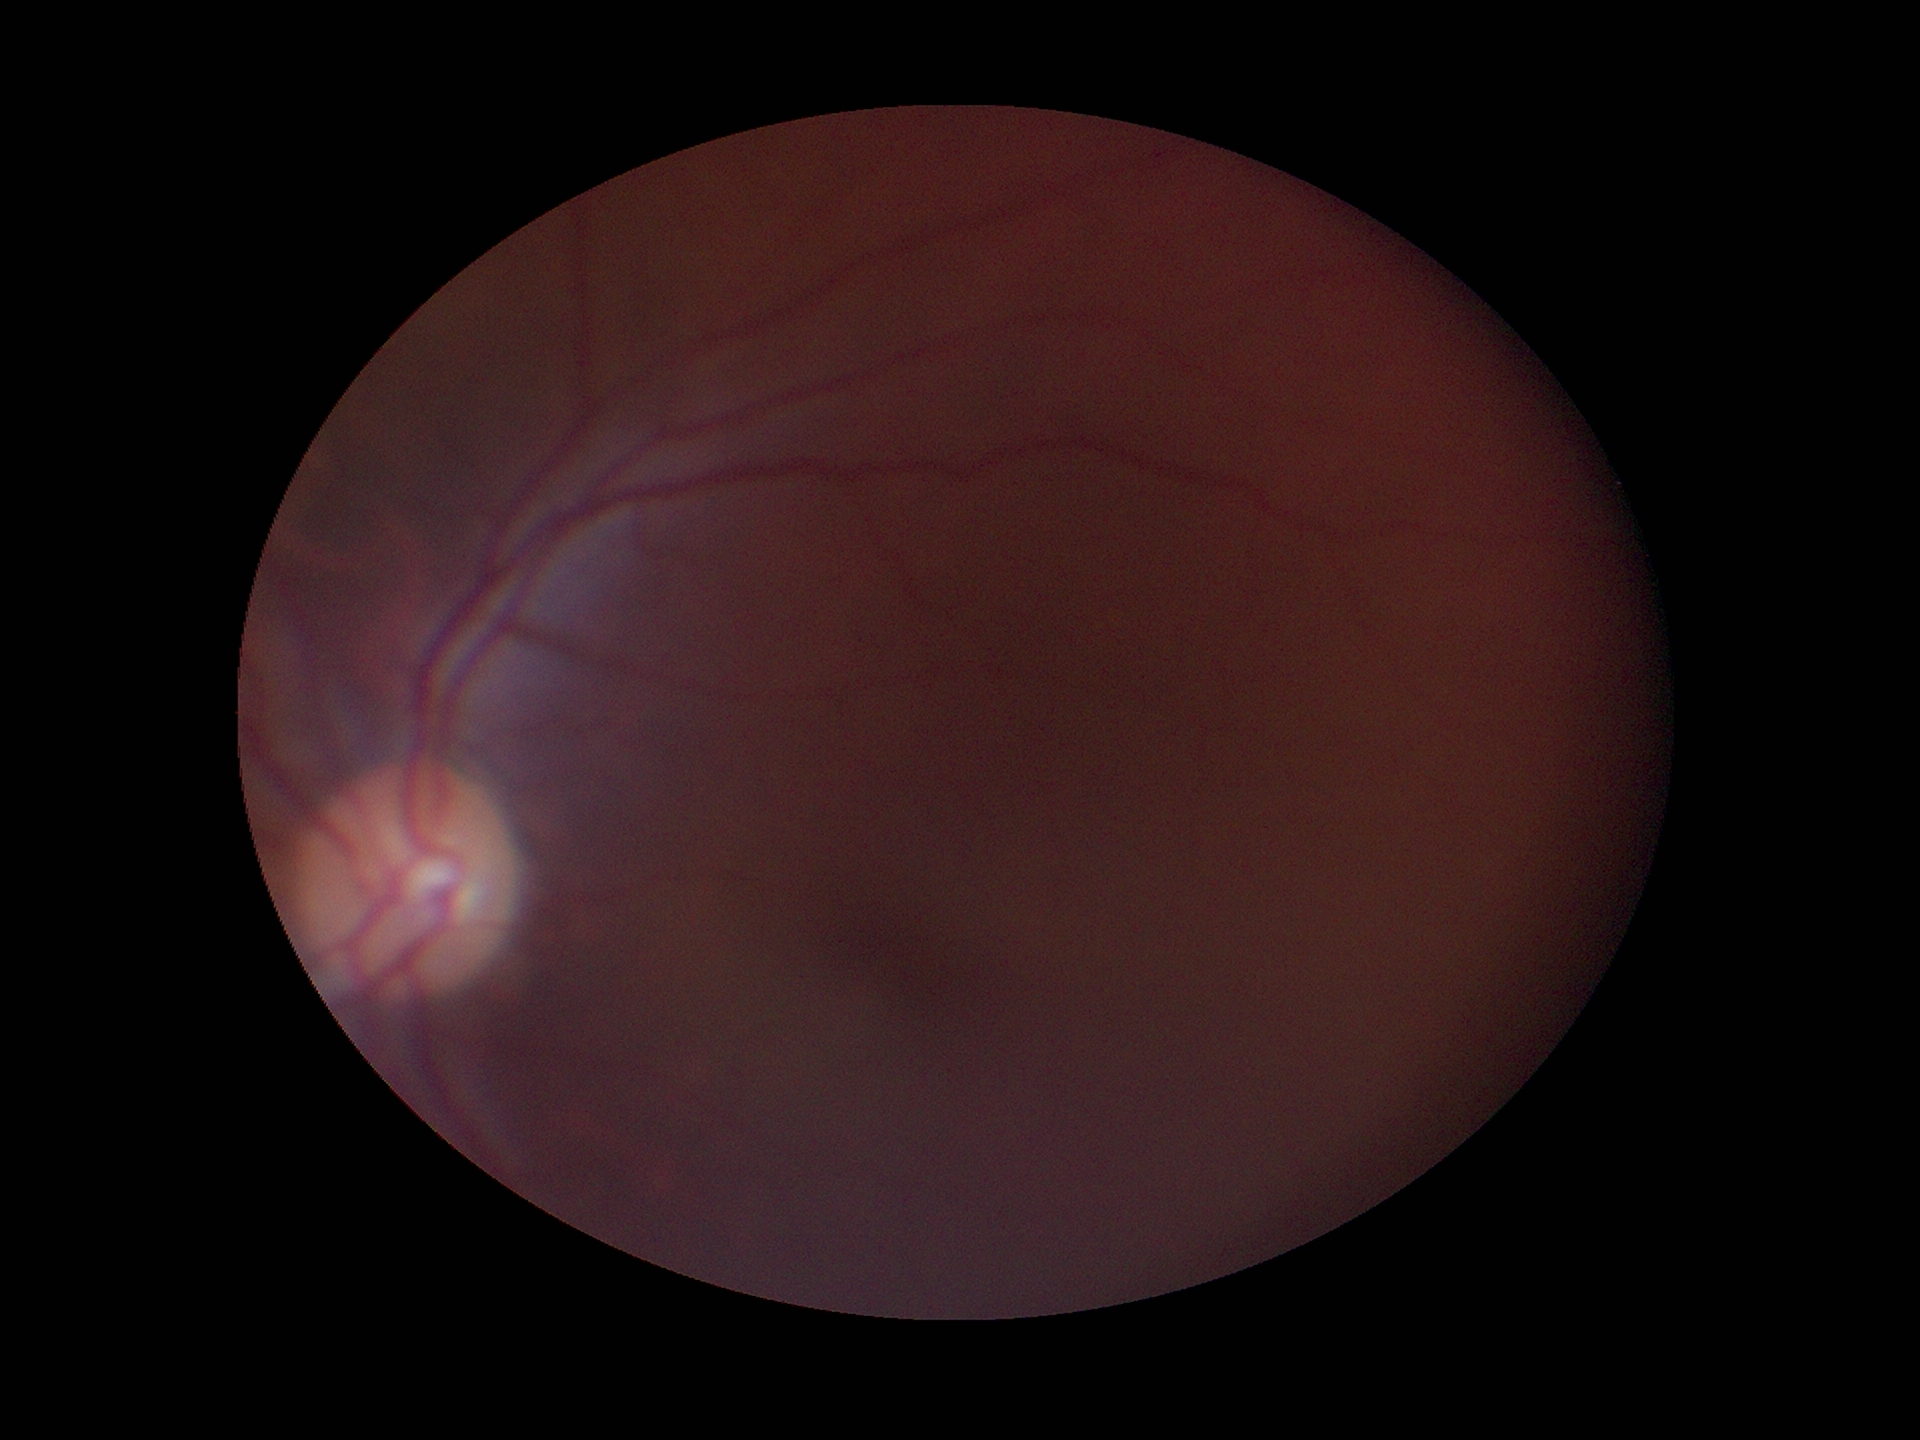
Vertical cup-to-disc ratio (VCDR) is 0.52. Glaucoma decision: no suspicious findings (1 of 5 graders flagged glaucoma suspect).